1240 by 1240 pixels. 100° field of view (Phoenix ICON). Phoenix ICON wide-field infant fundus image:
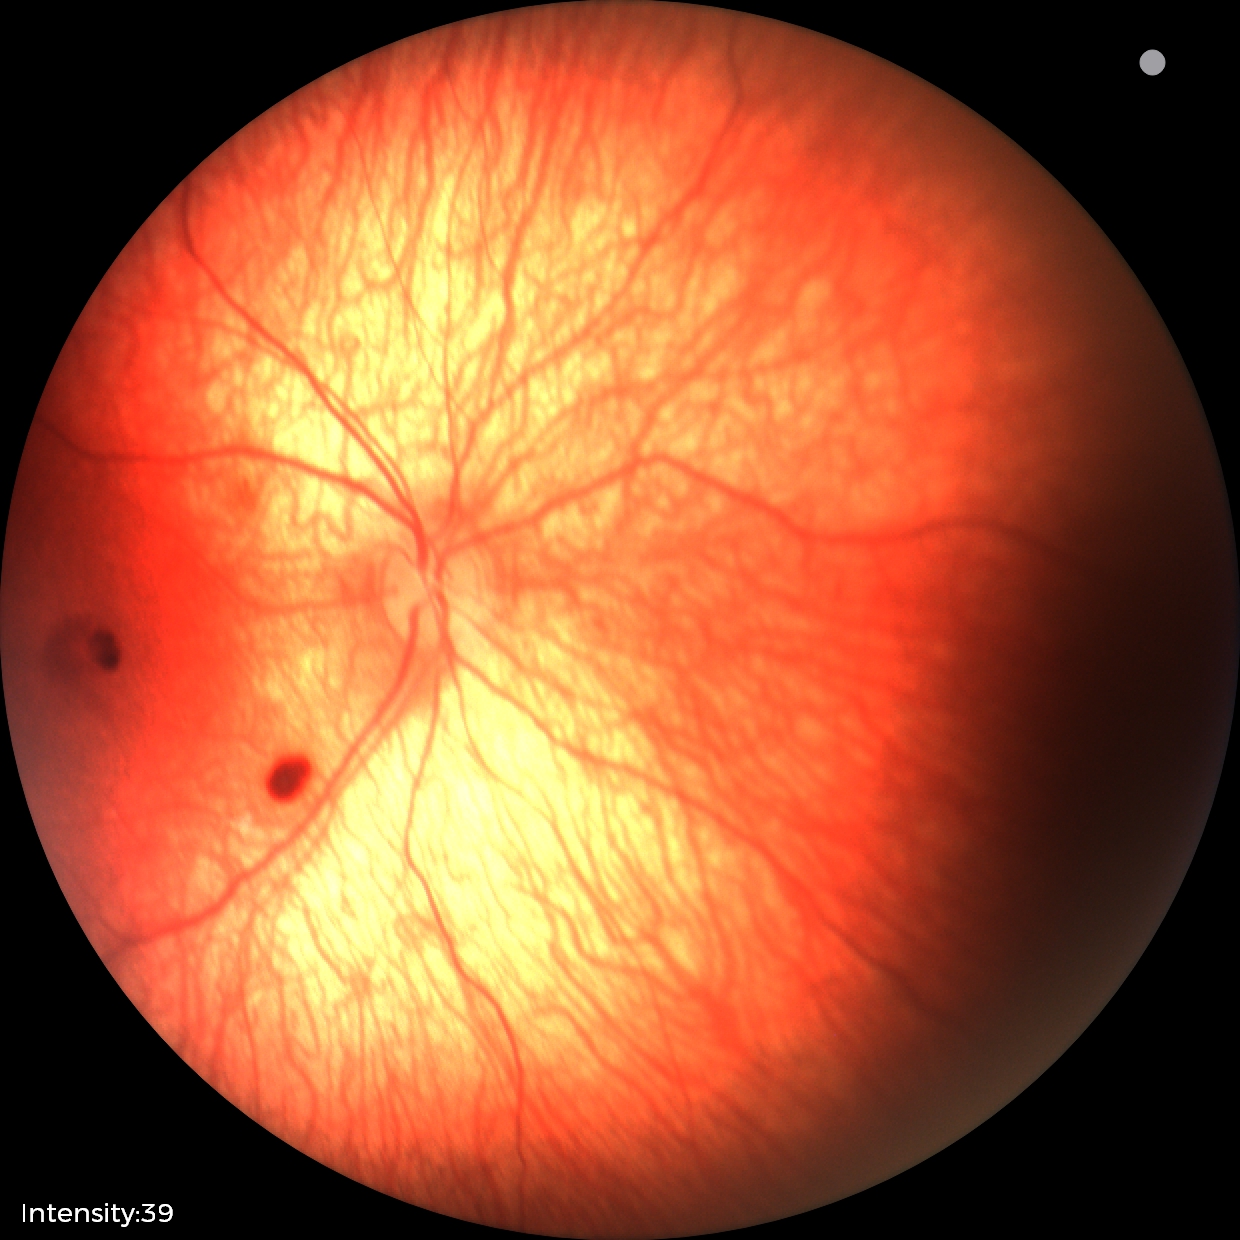

Screening series with retinal hemorrhages.